DR severity per modified Davis staging.
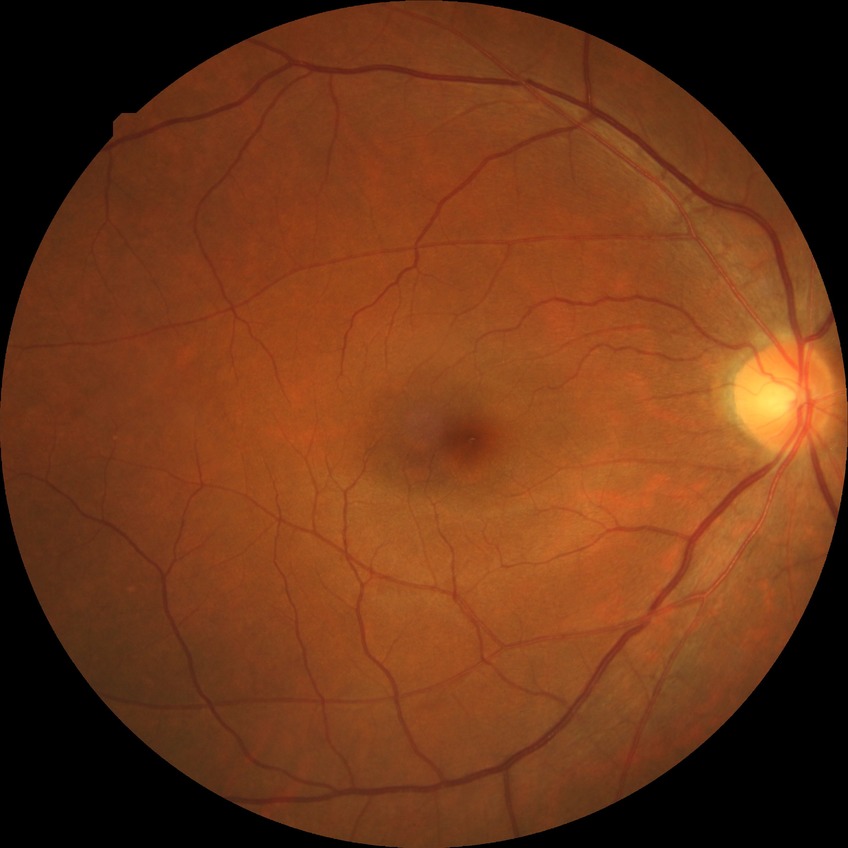

Davis grading: no diabetic retinopathy.